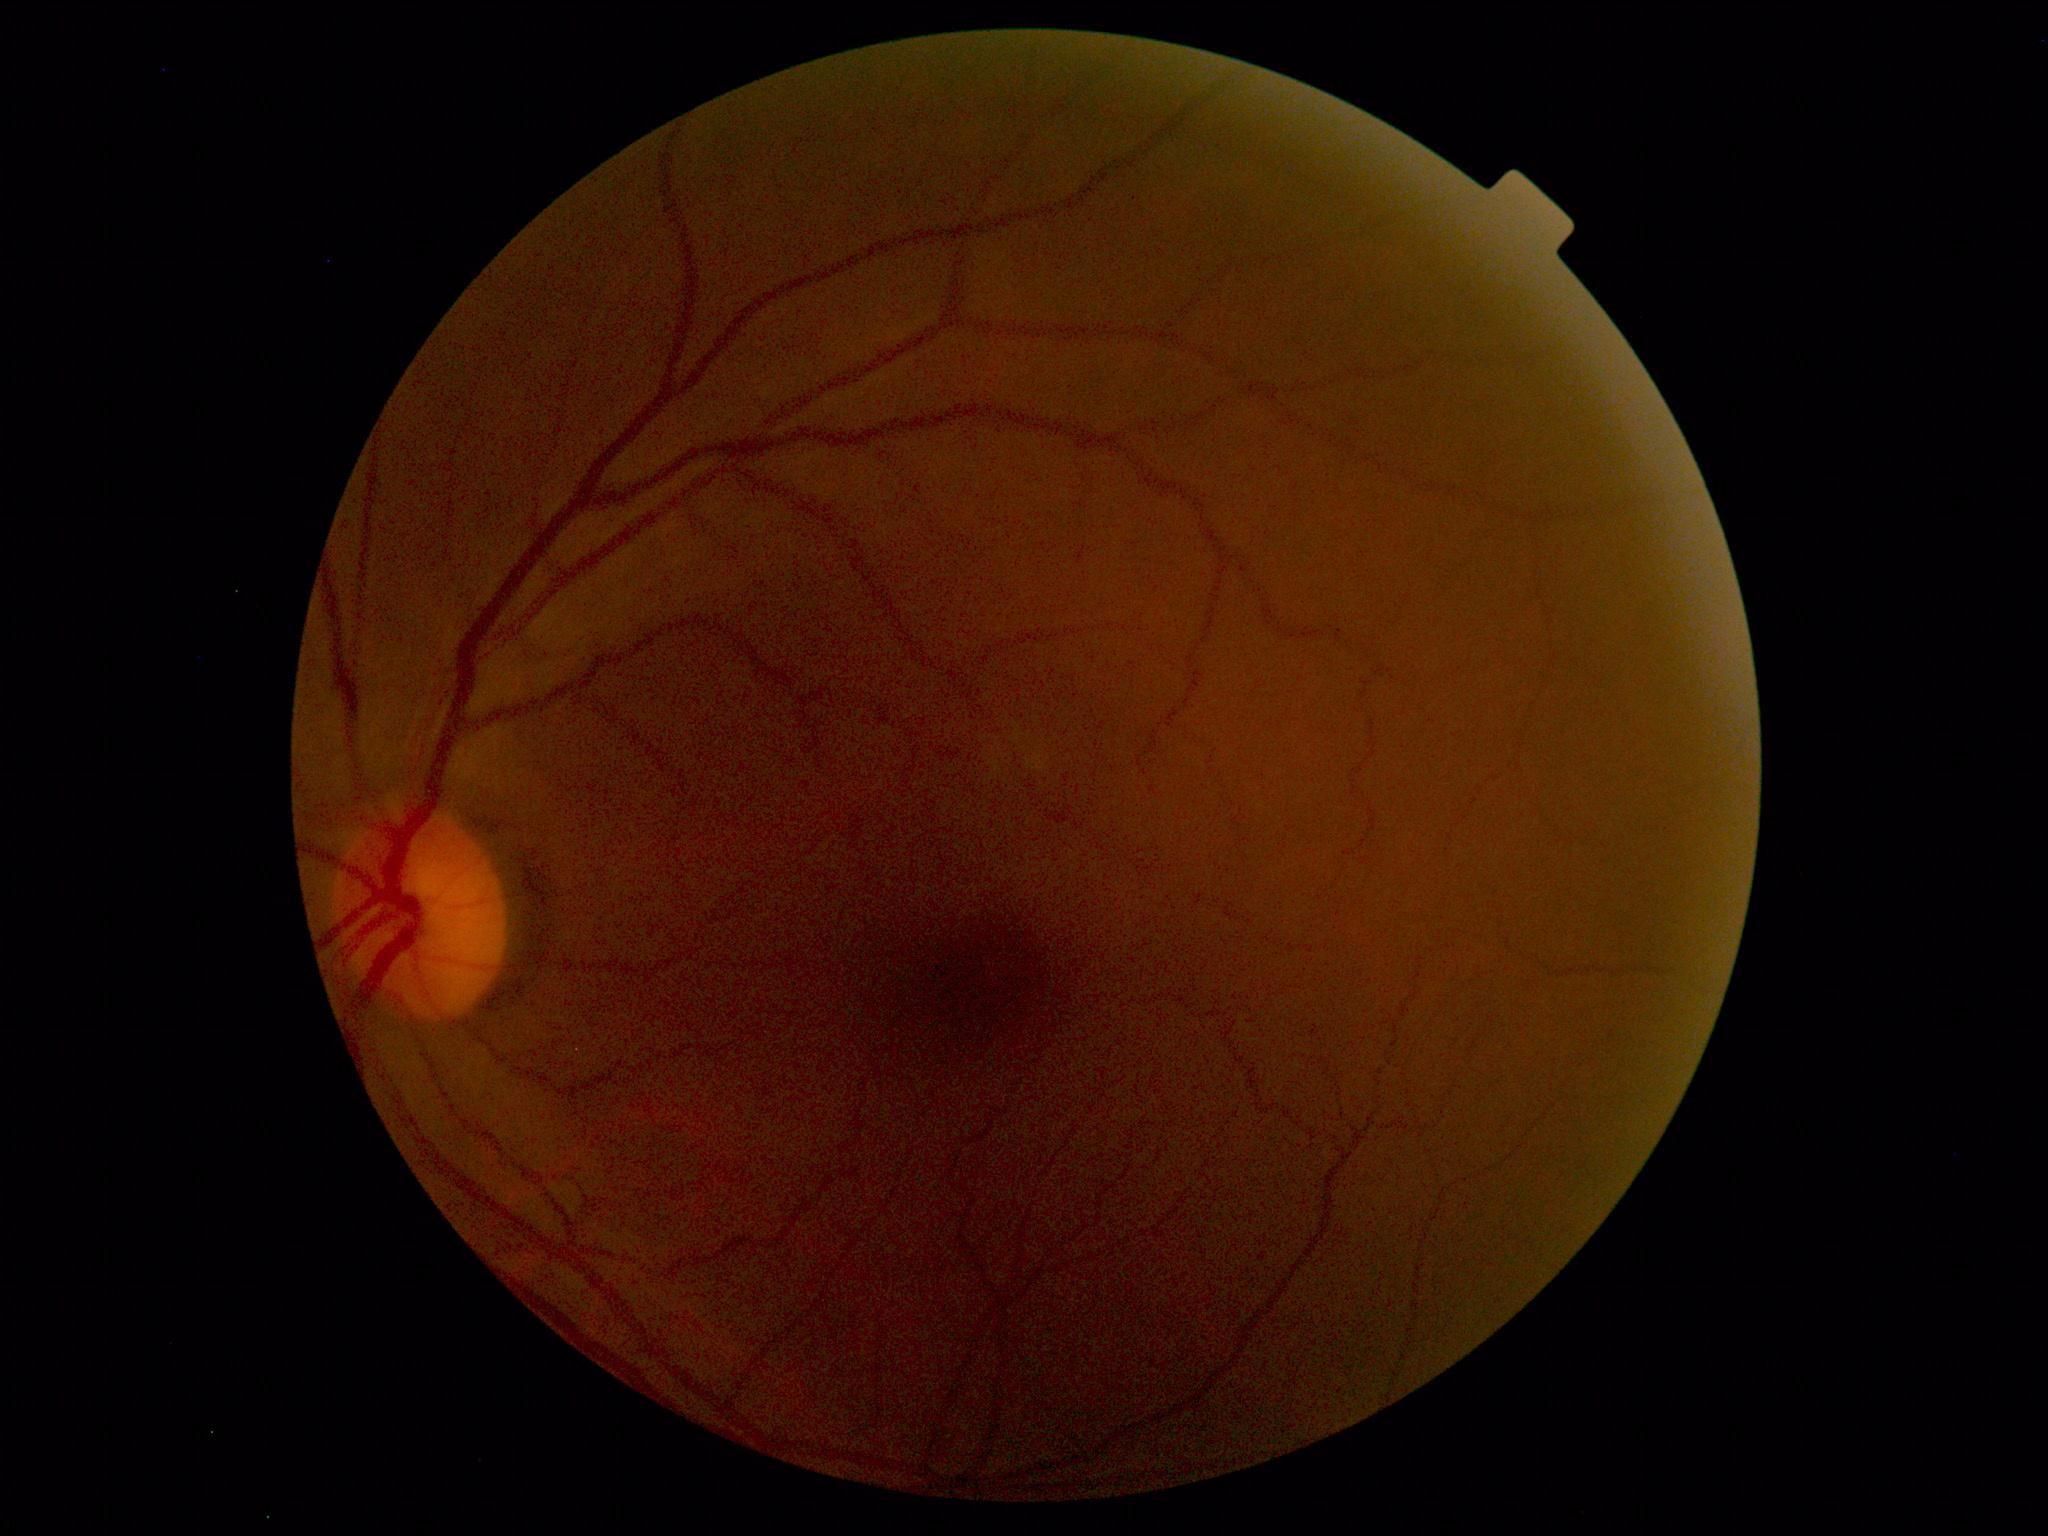
Impression: normal fundus.